Pediatric wide-field fundus photograph: 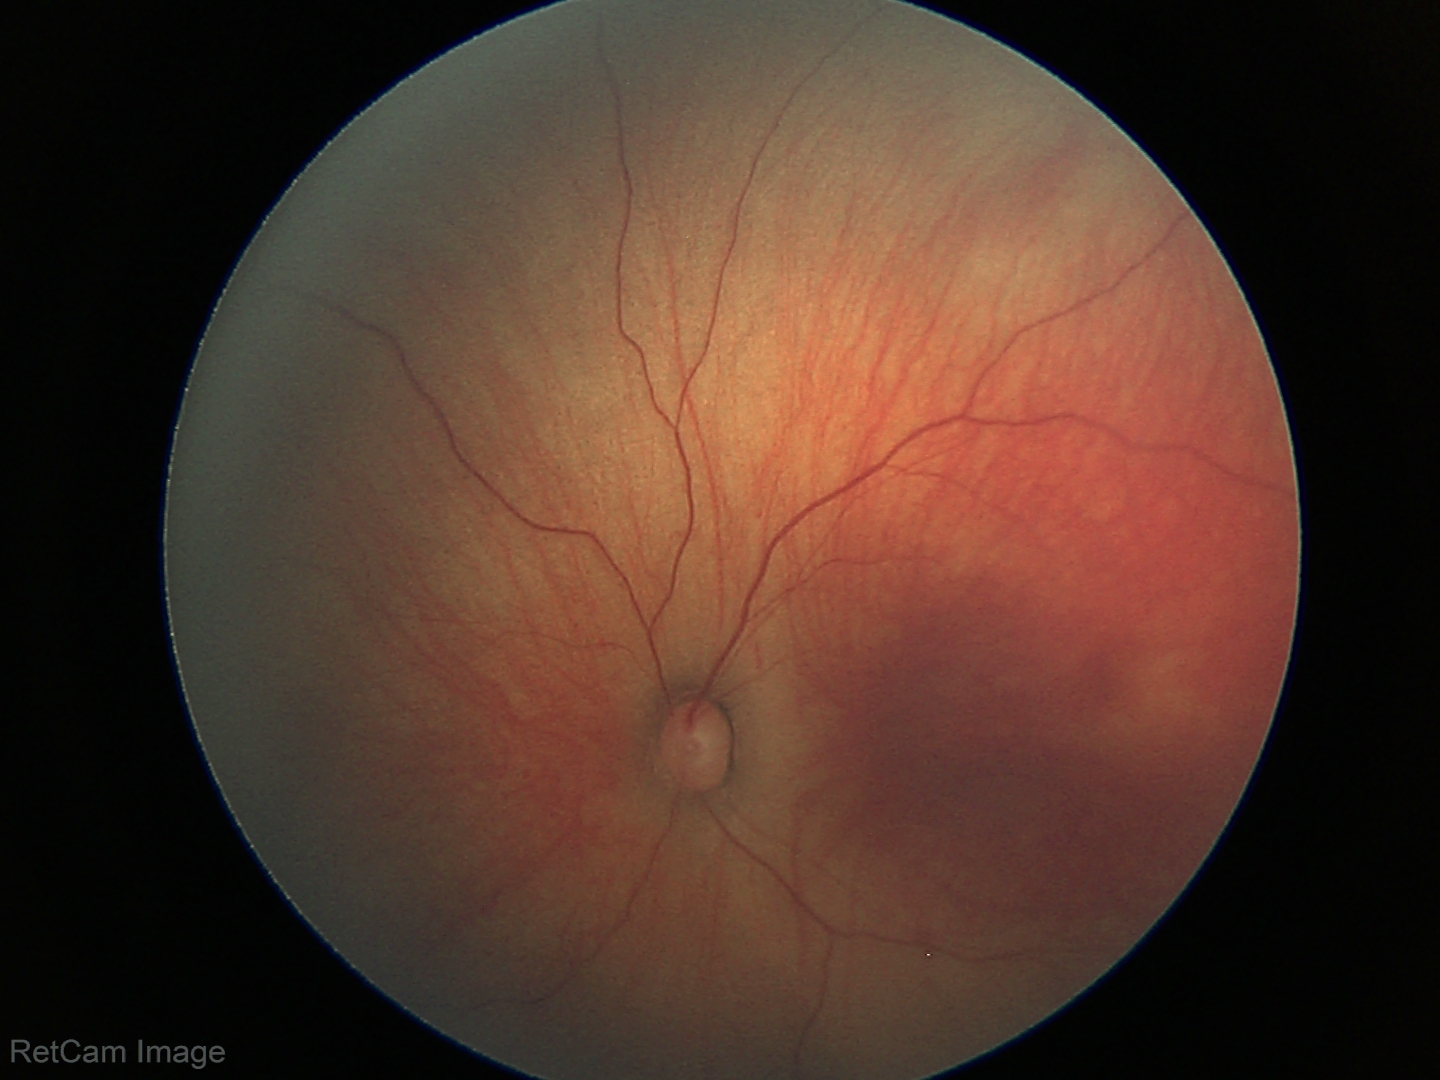
Screening examination with no abnormal retinal findings.